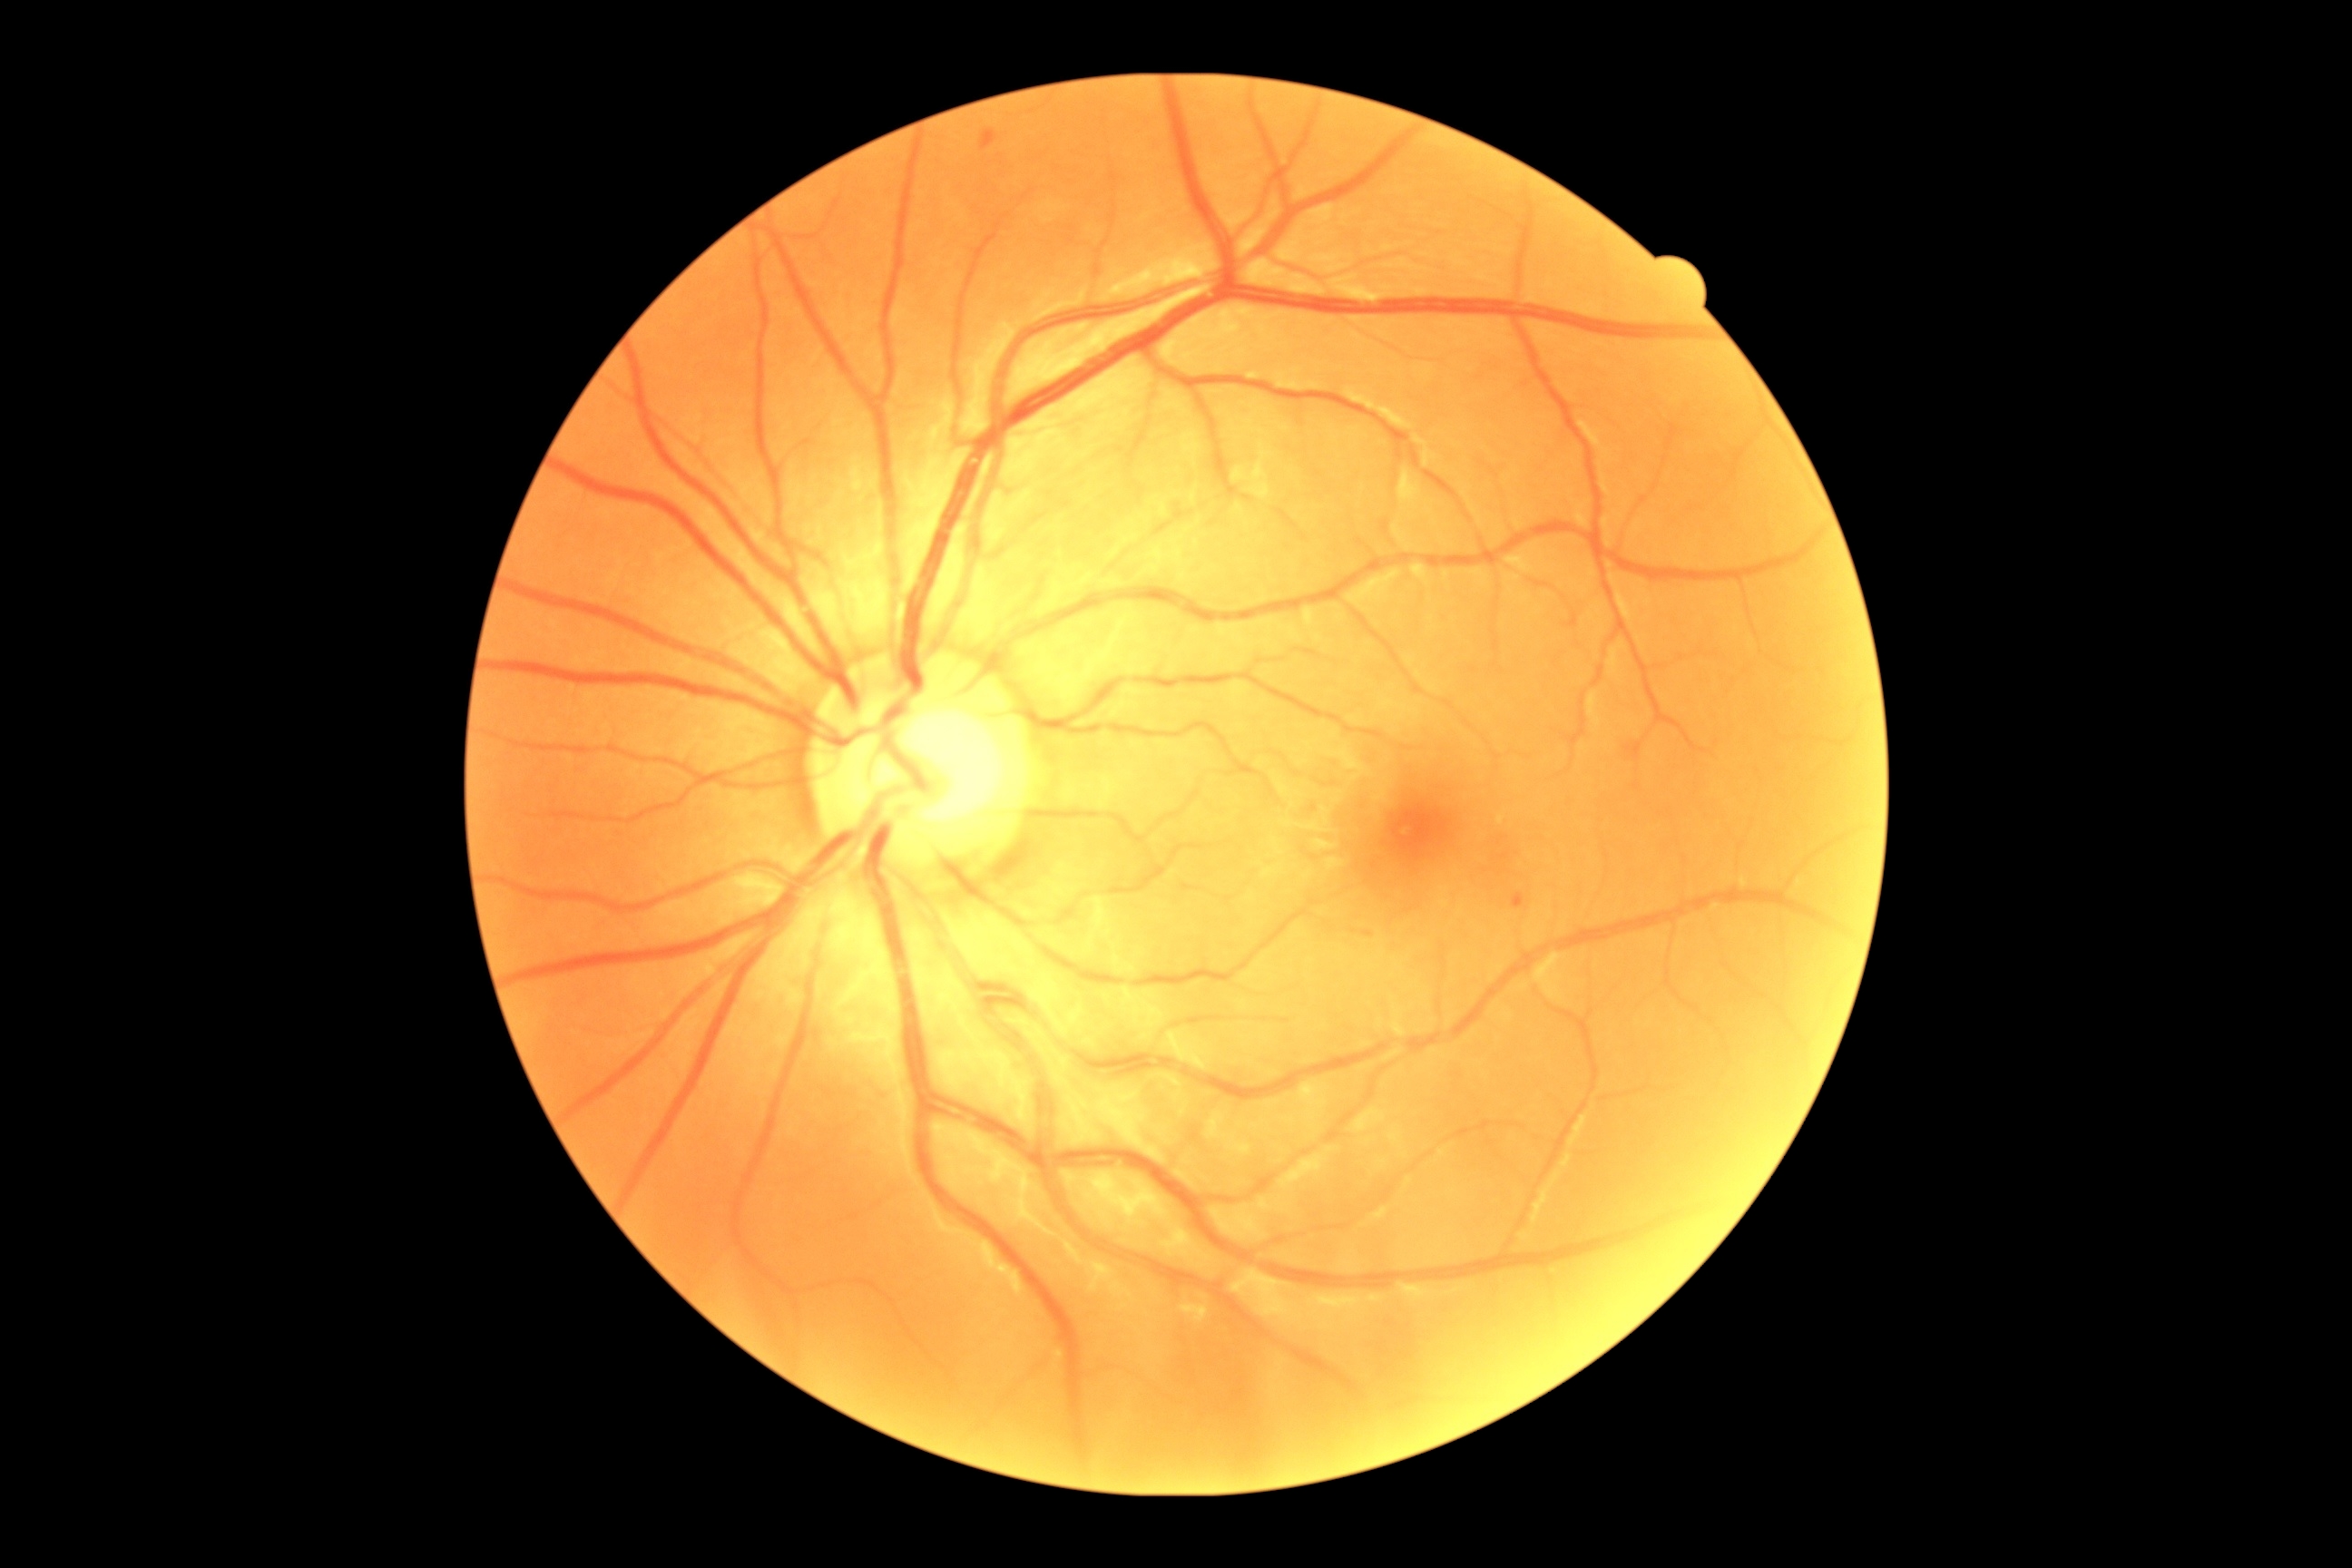 Findings:
• DR: mild NPDR (grade 1)